Color fundus photograph; acquired with a Remidio smartphone fundus camera; image size 1659x2212
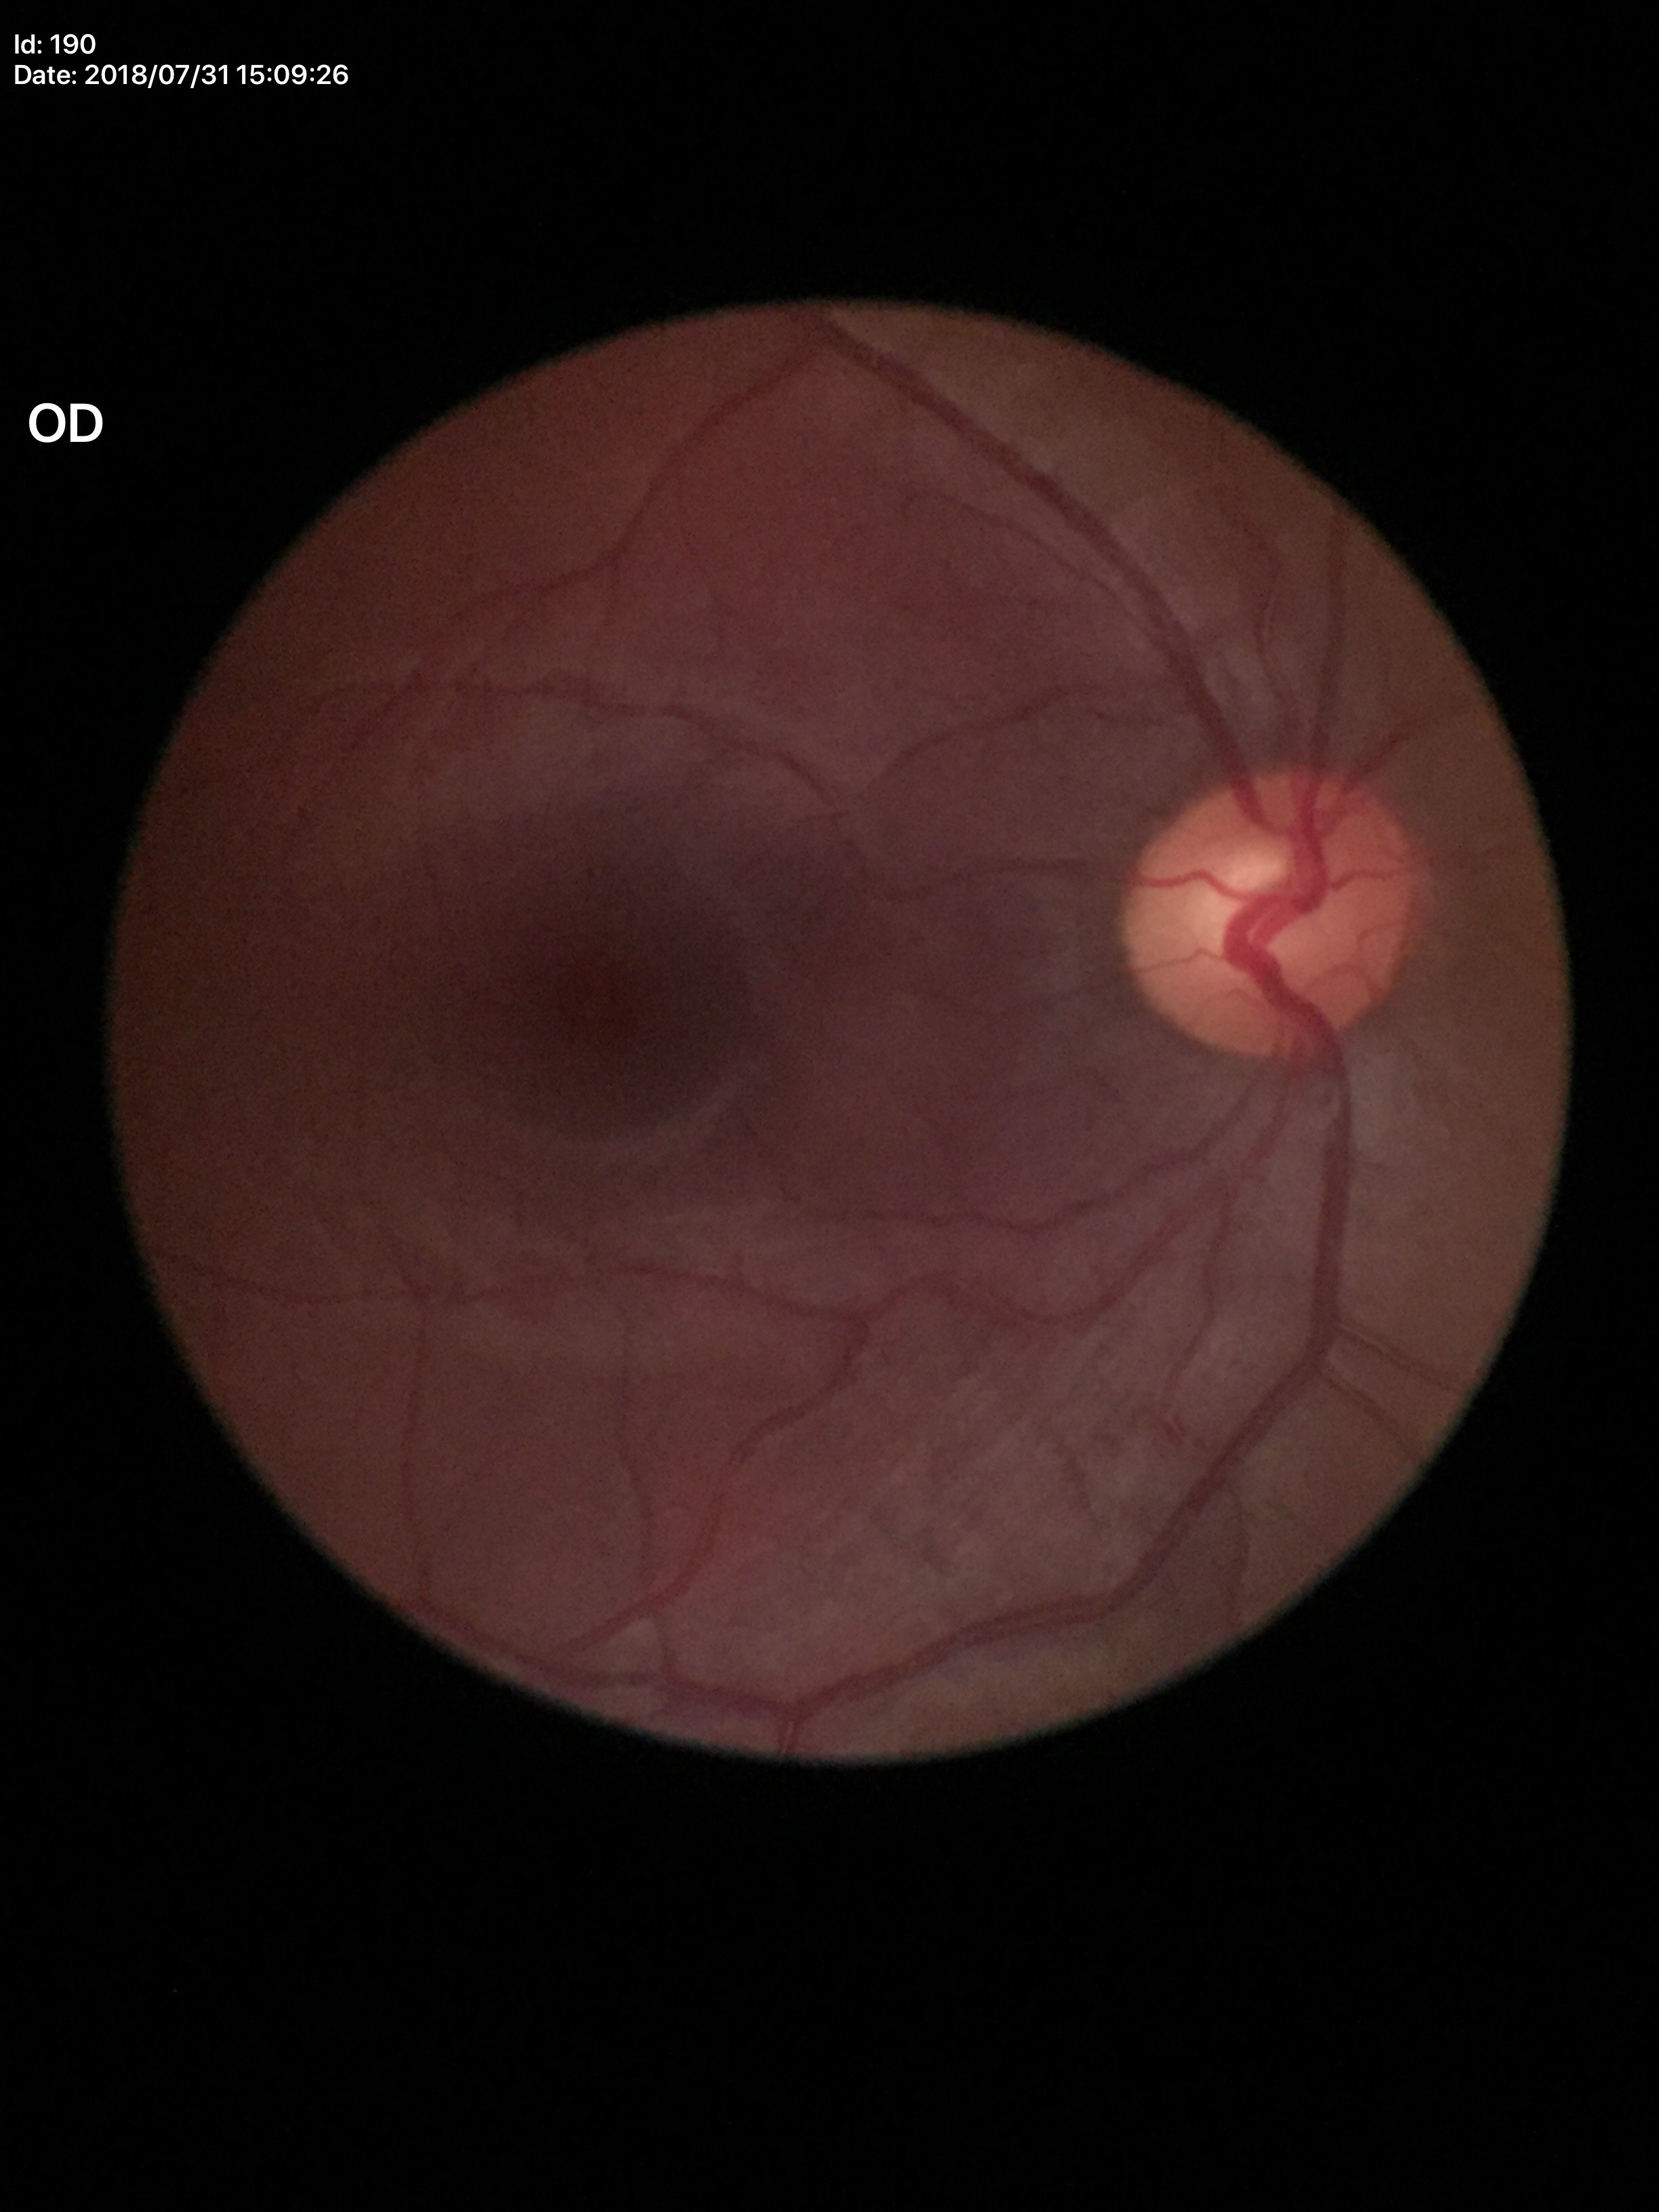

Glaucoma evaluation: negative | vertical cup-disc ratio (VCDR): 0.56 | horizontal cup-disc ratio (HCDR): 0.56.